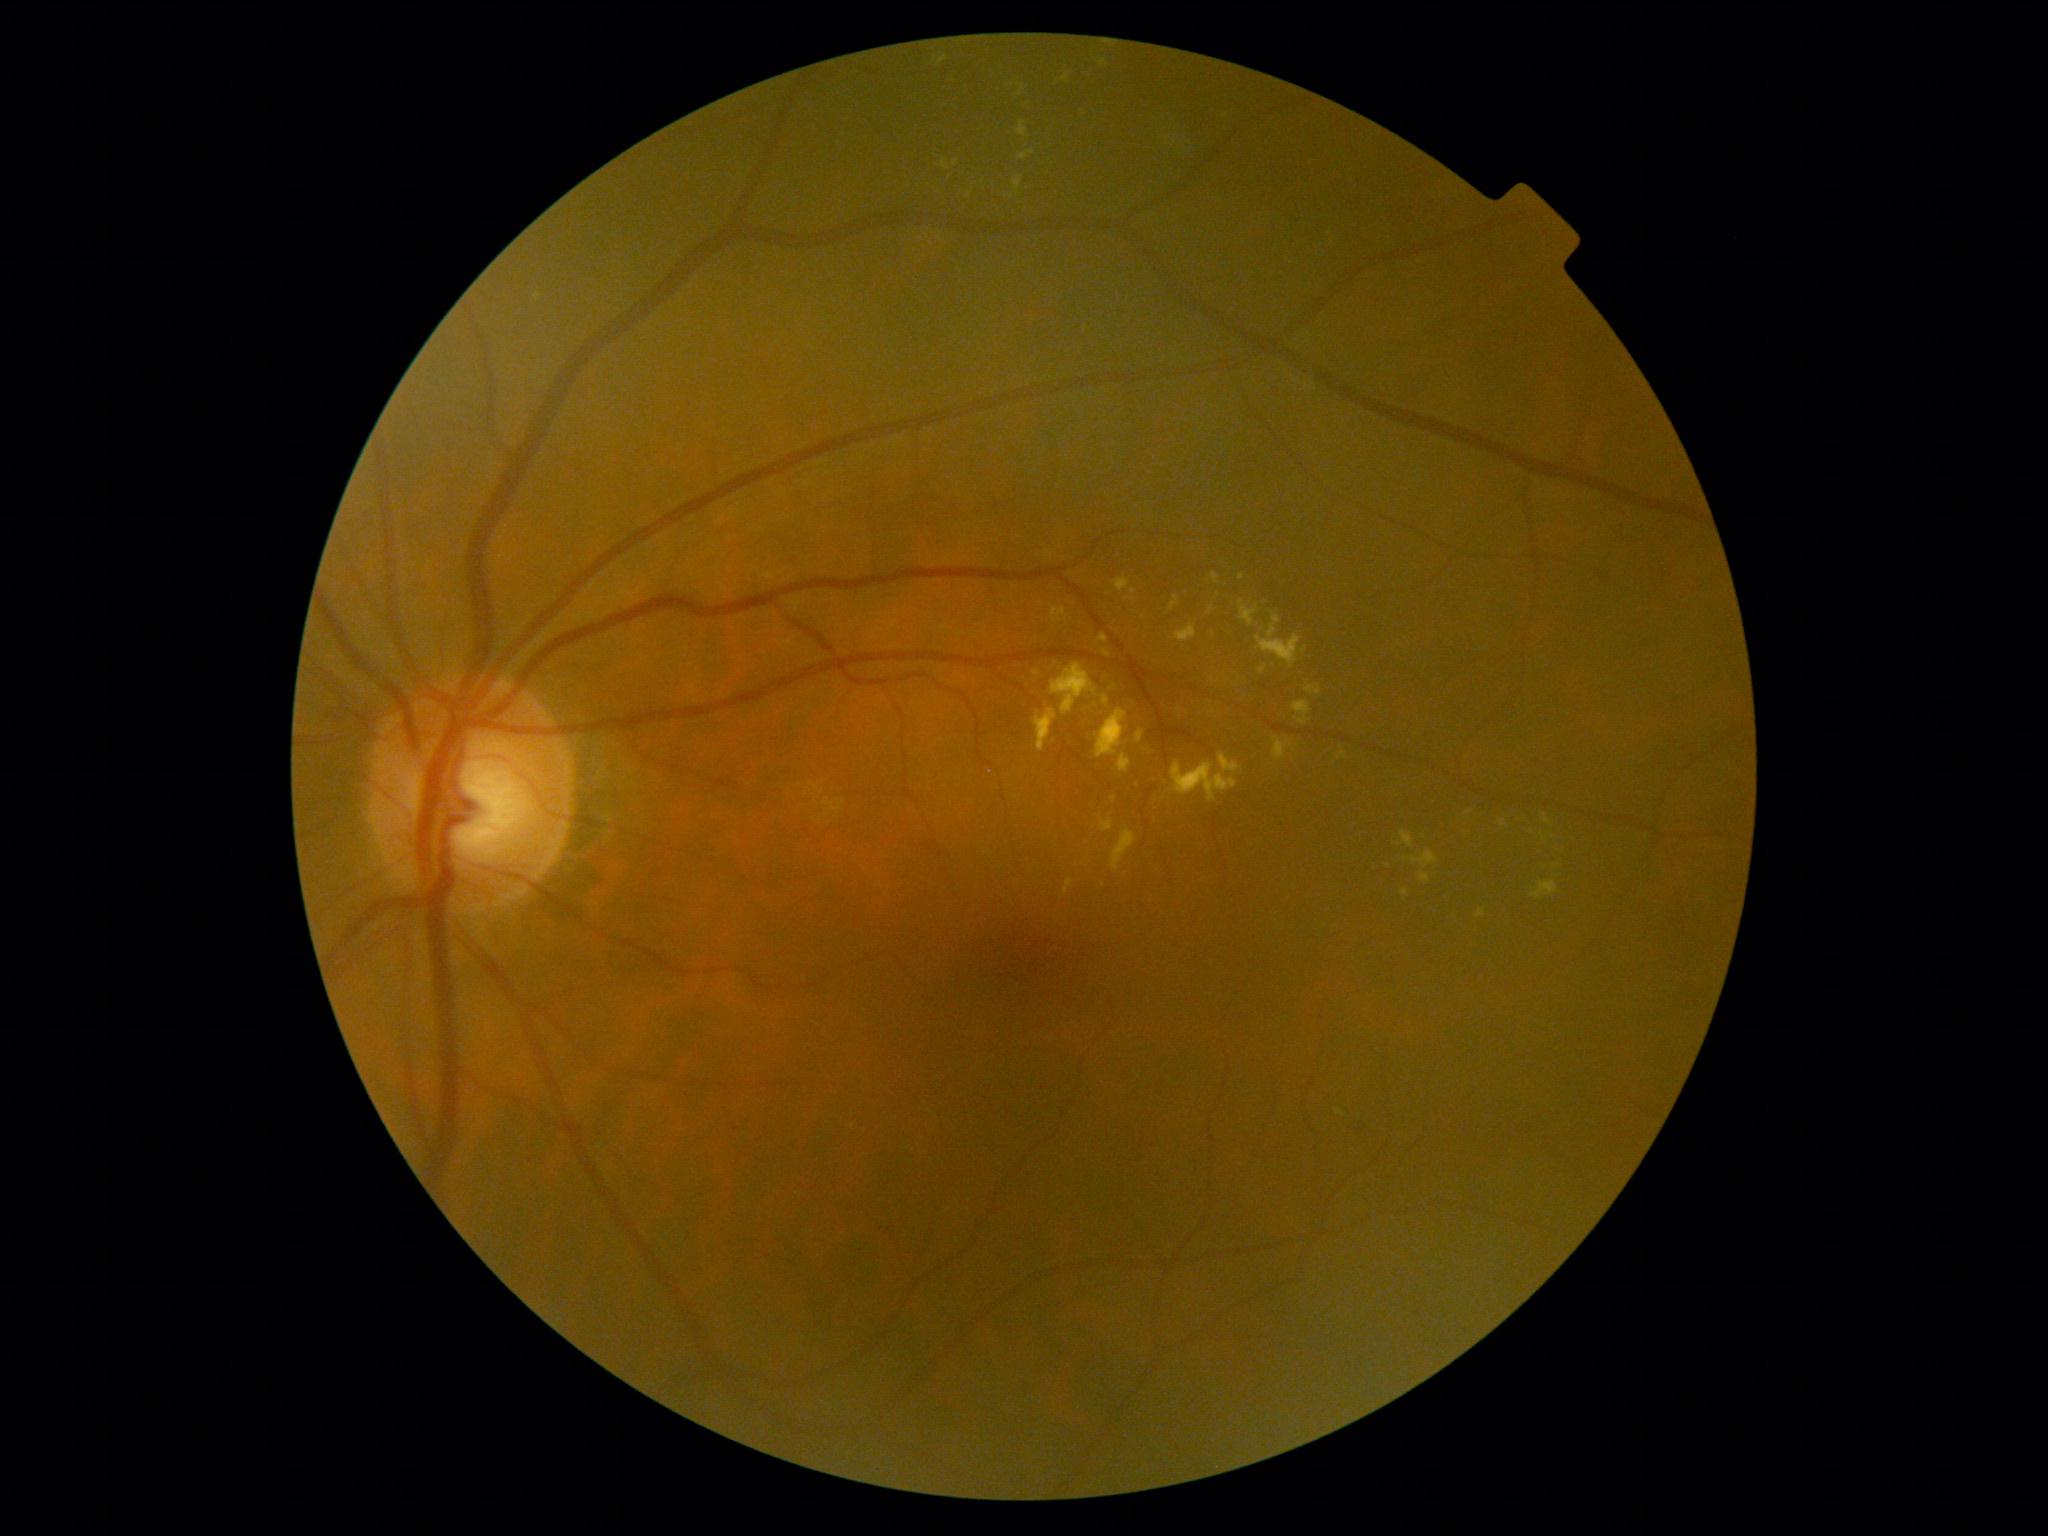
DR stage is grade 2 (moderate NPDR)
Selected lesions:
• EXs (partial): 1532/882/1561/901; 1256/615/1301/667; 1420/874/1430/884; 1335/1109/1345/1117; 1017/120/1028/138; 1292/701/1311/726; 1014/176/1023/195; 1051/608/1067/624; 942/159/951/171; 1541/833/1549/842
• Small EXs near pt(1133, 600); pt(1012, 196); pt(969, 195); pt(1106, 654); pt(1180, 711)